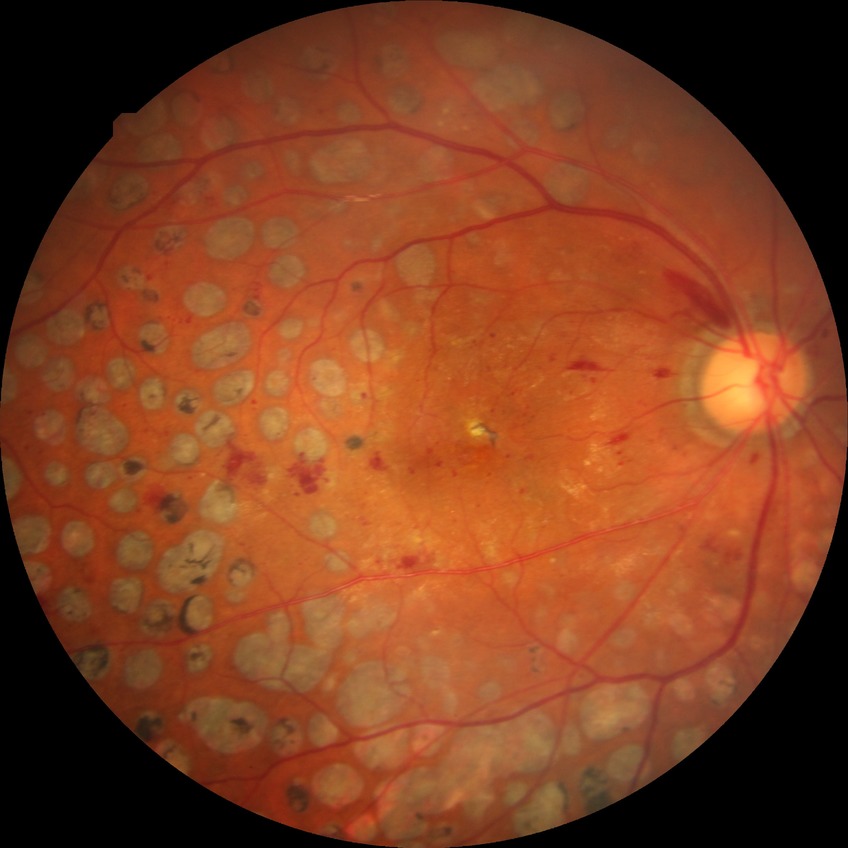
* Davis stage — PDR